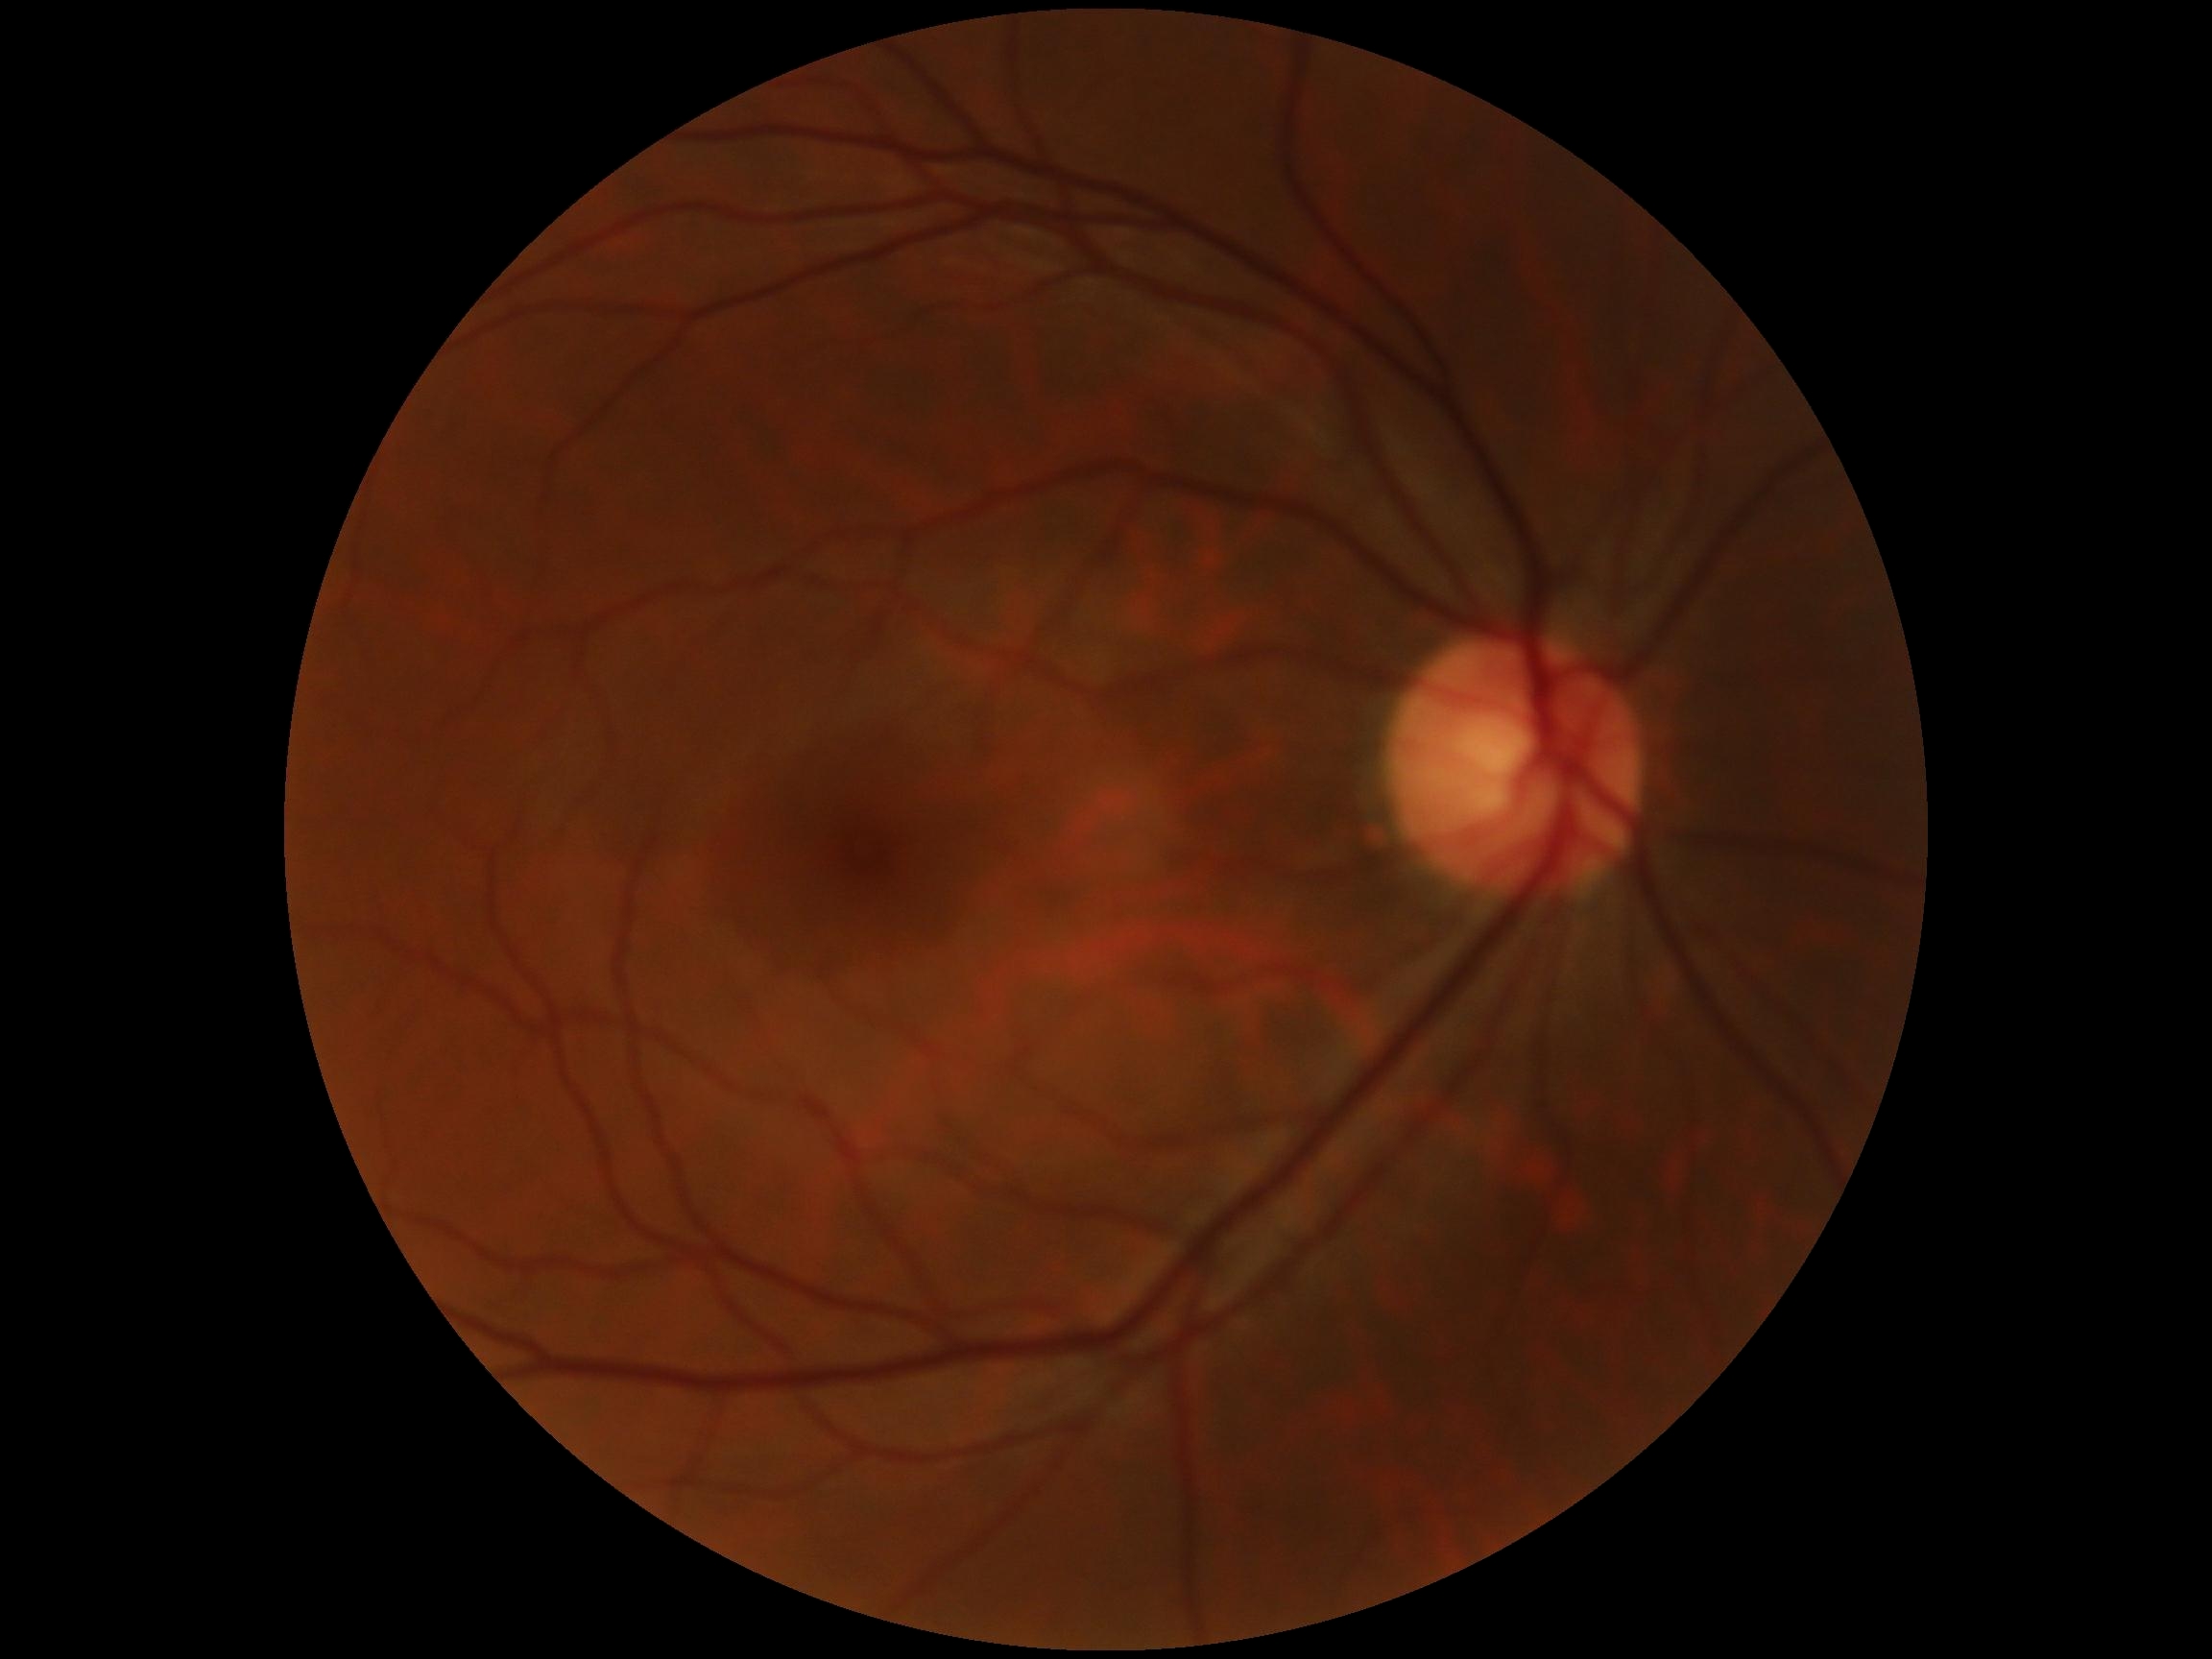

Diabetic retinopathy grade is 0 (no apparent retinopathy) — no visible signs of diabetic retinopathy.